Infant wide-field retinal image. Image size 1240x1240. Camera: Phoenix ICON (100° FOV): 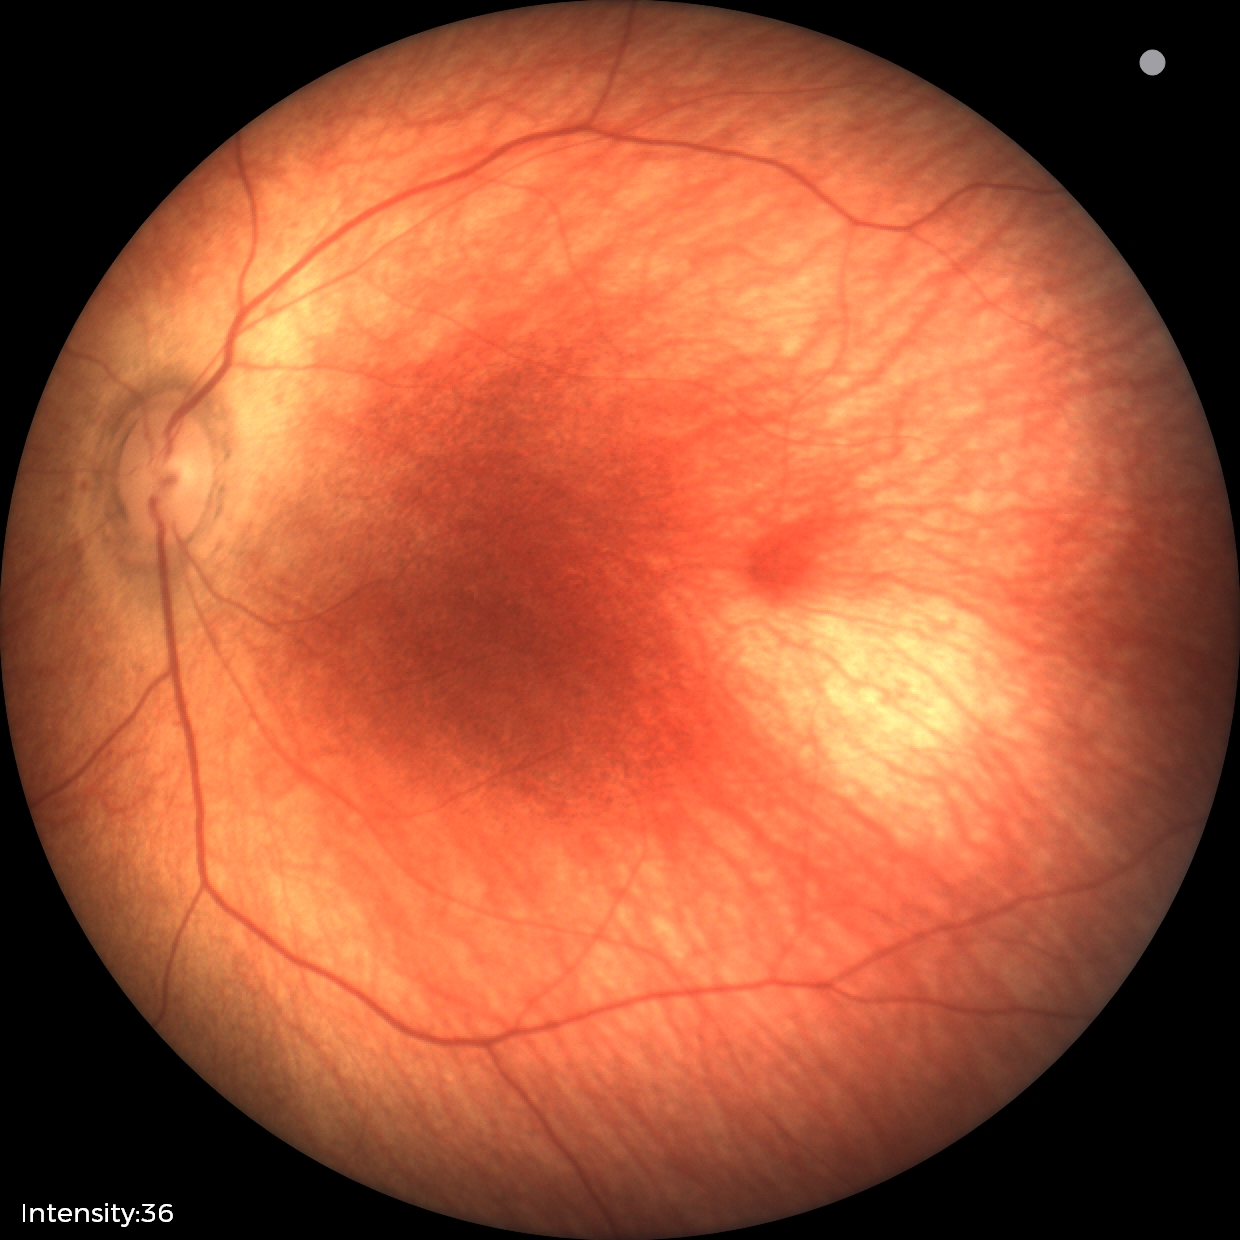

Normal screening examination.